Fundus photo, 2352 x 1568 pixels:
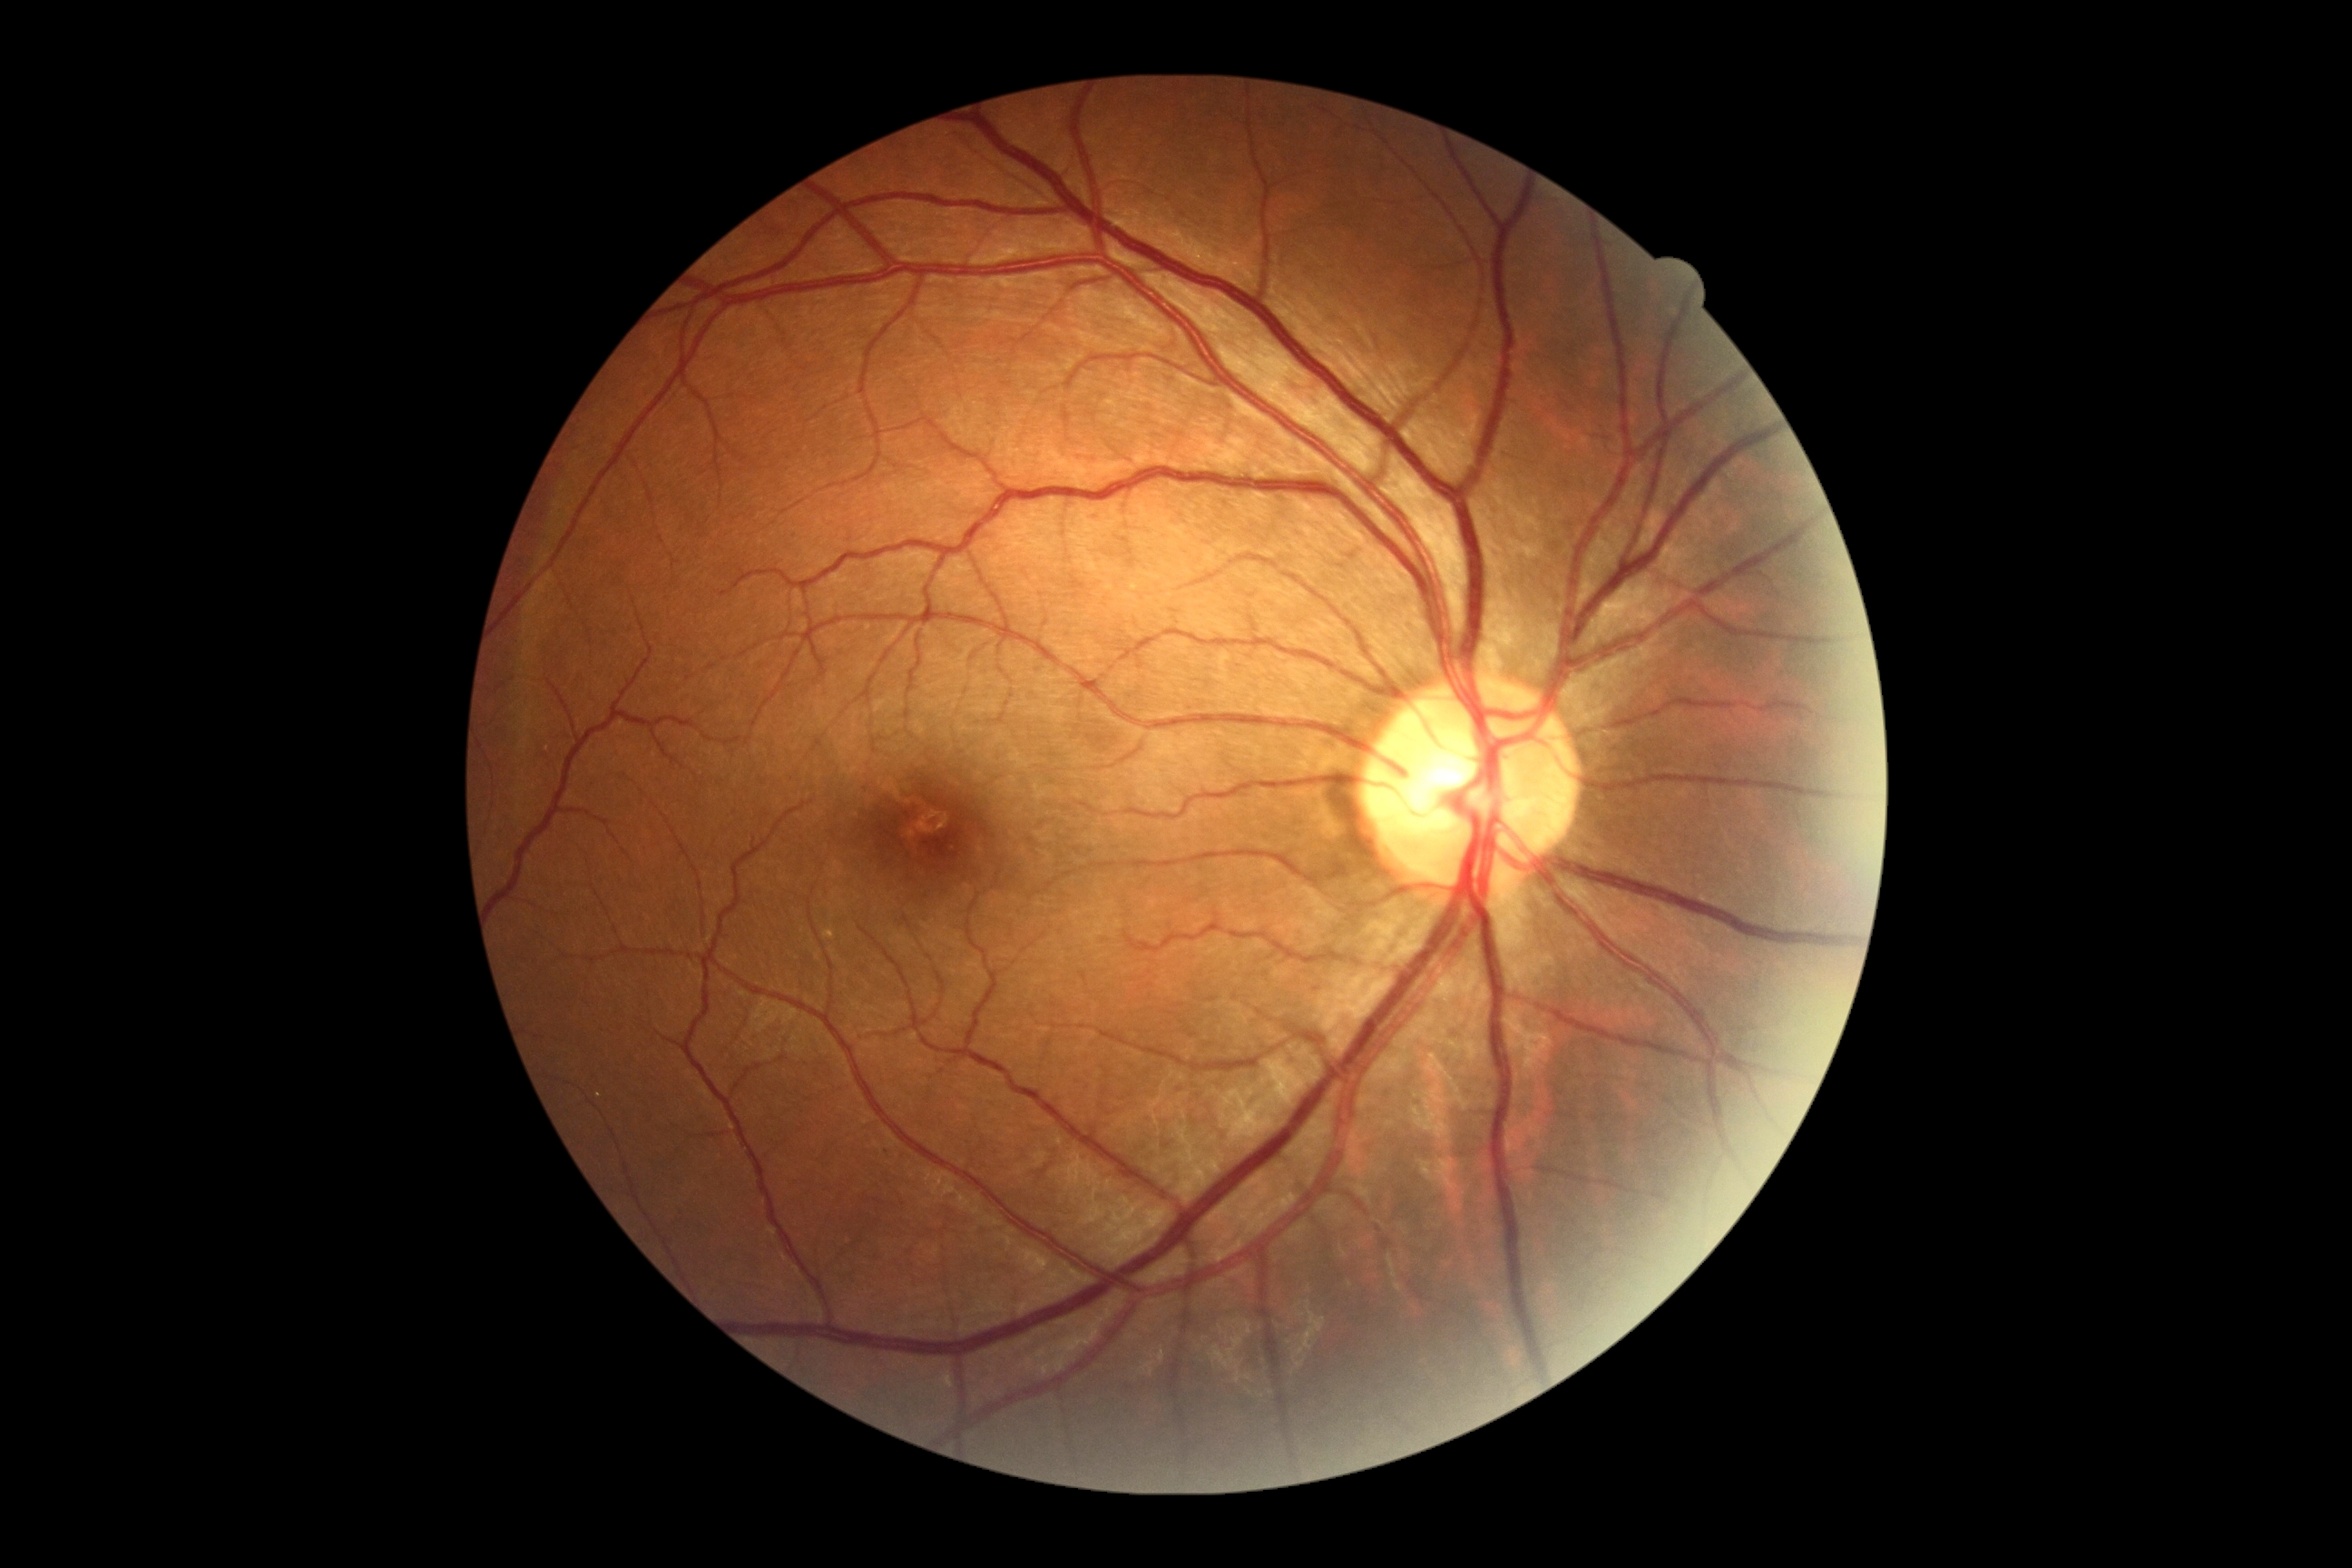 DR grade is 0. No diabetic retinal disease findings.